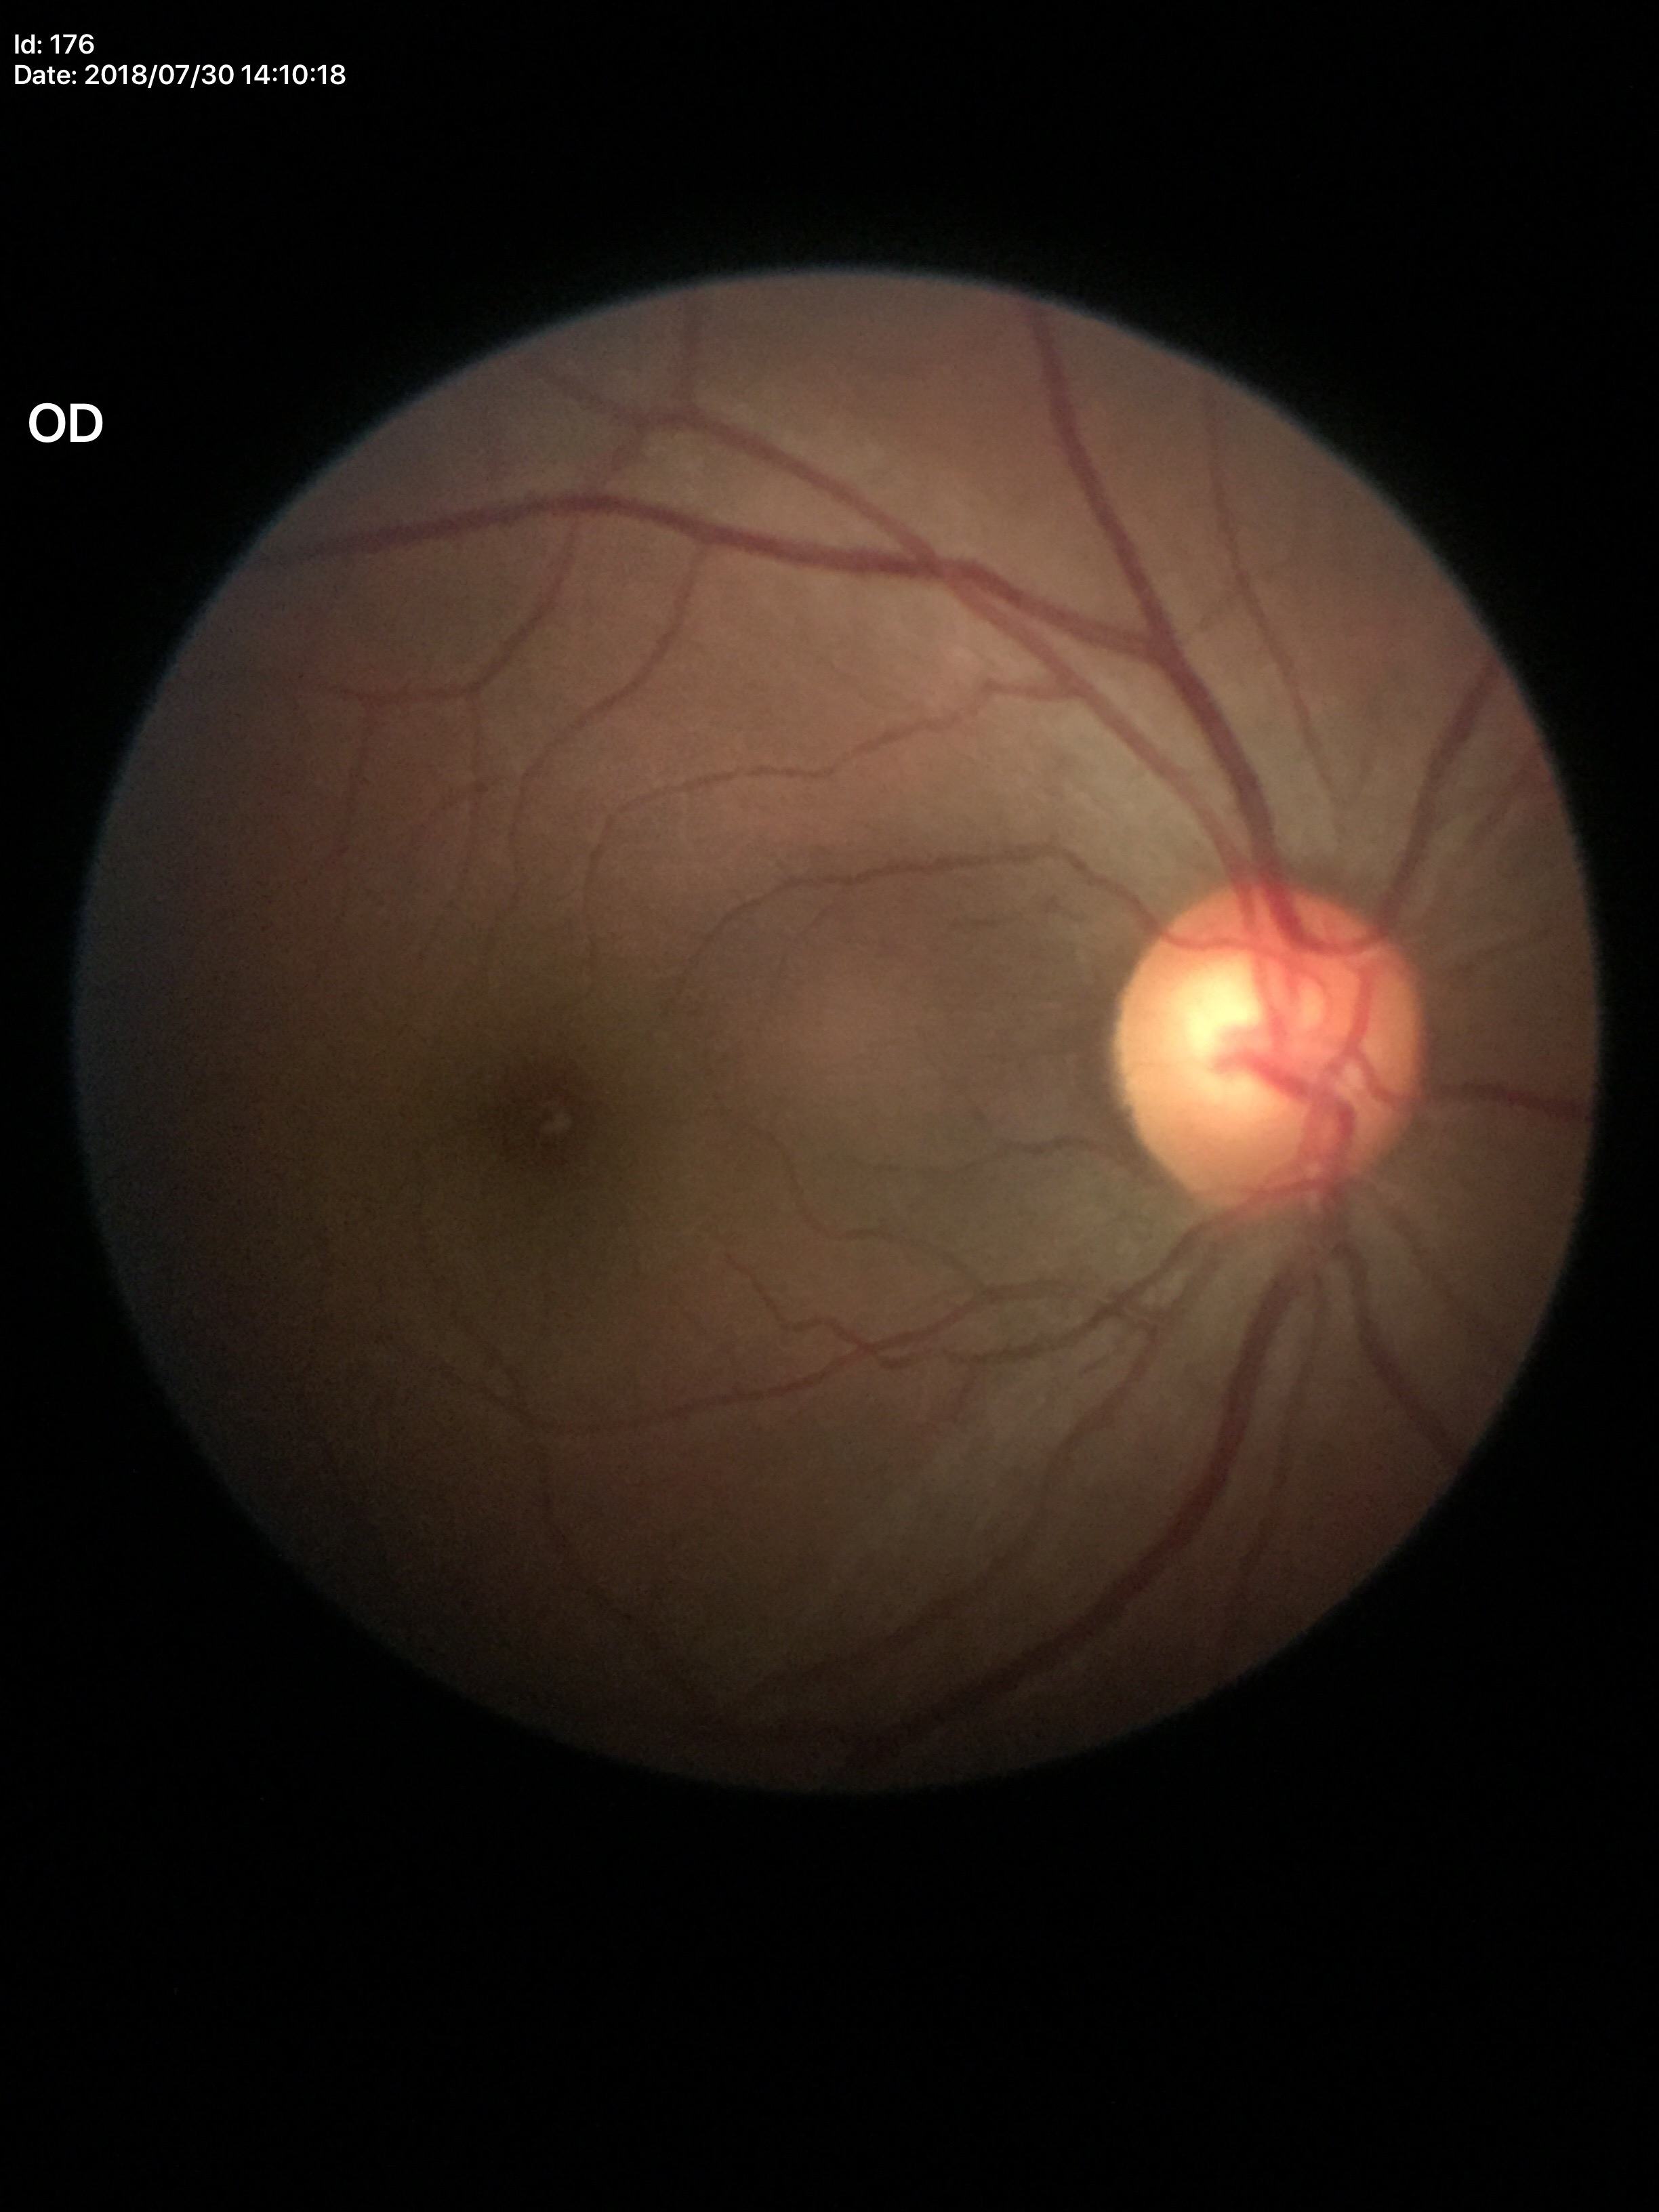
Optic disc analysis:
* VCDR: 0.59
* Glaucoma impression: not suspect